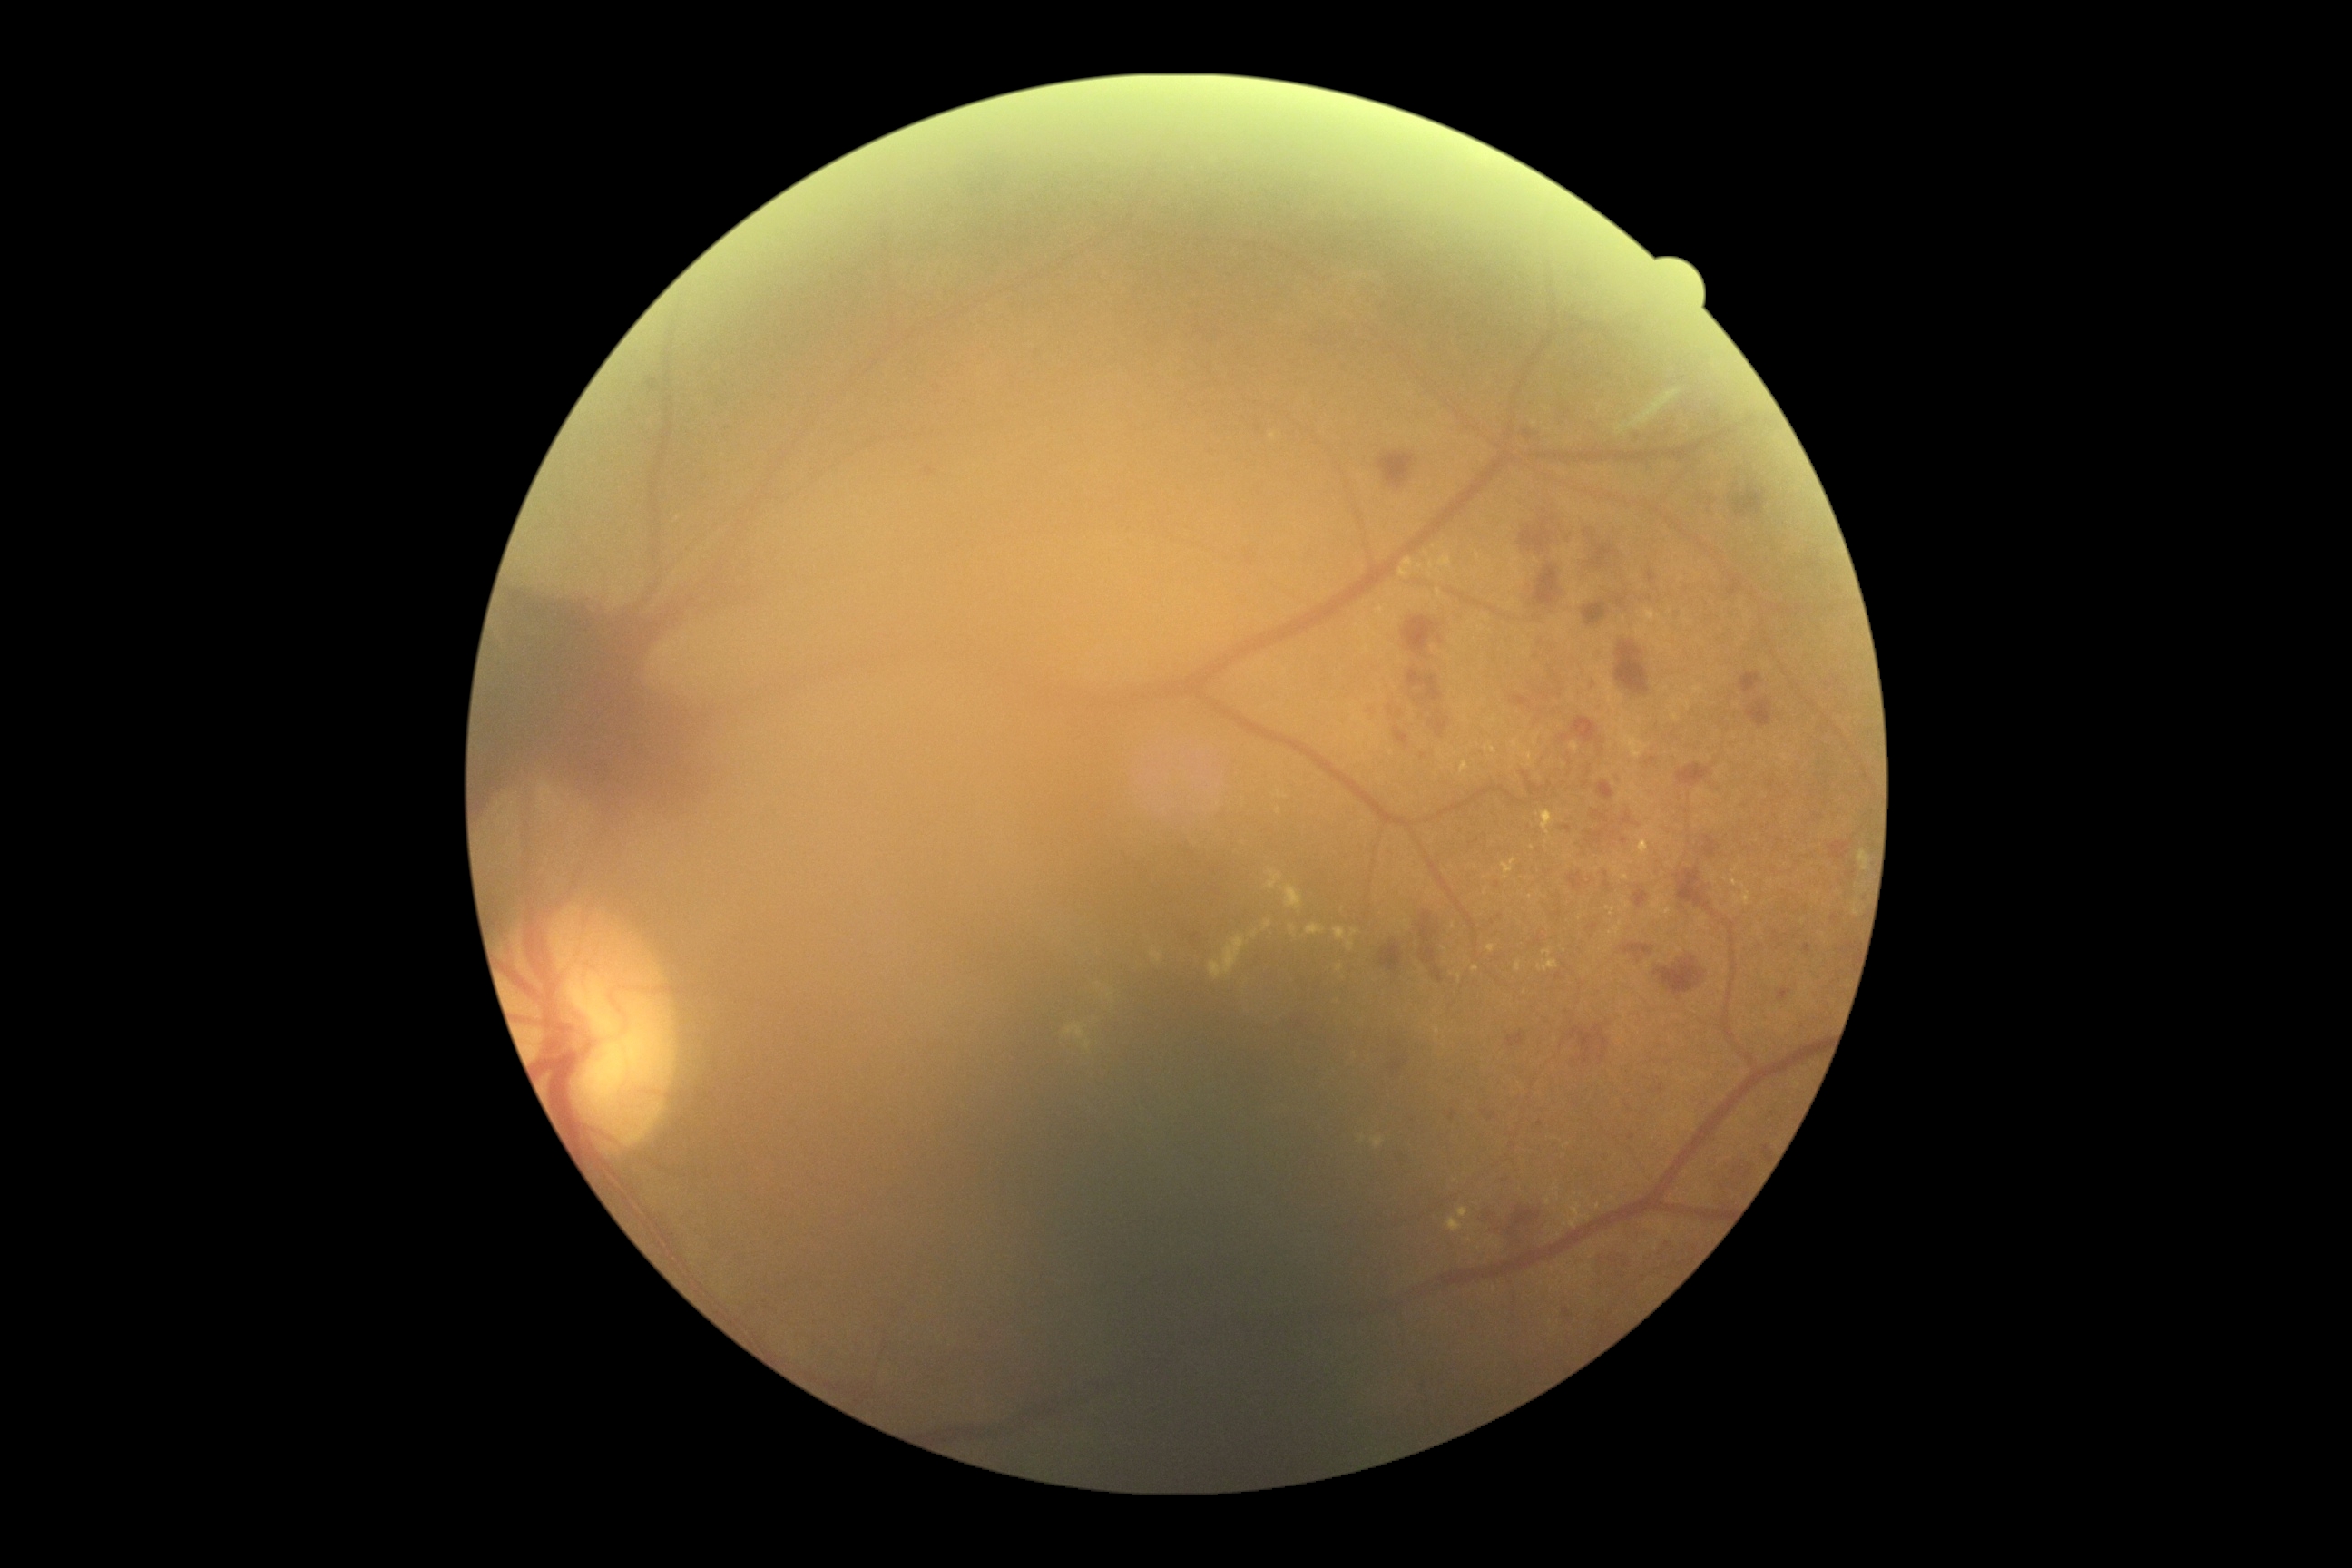 retinopathy grade = 4 (PDR) — neovascularization and/or vitreous/pre-retinal hemorrhage.